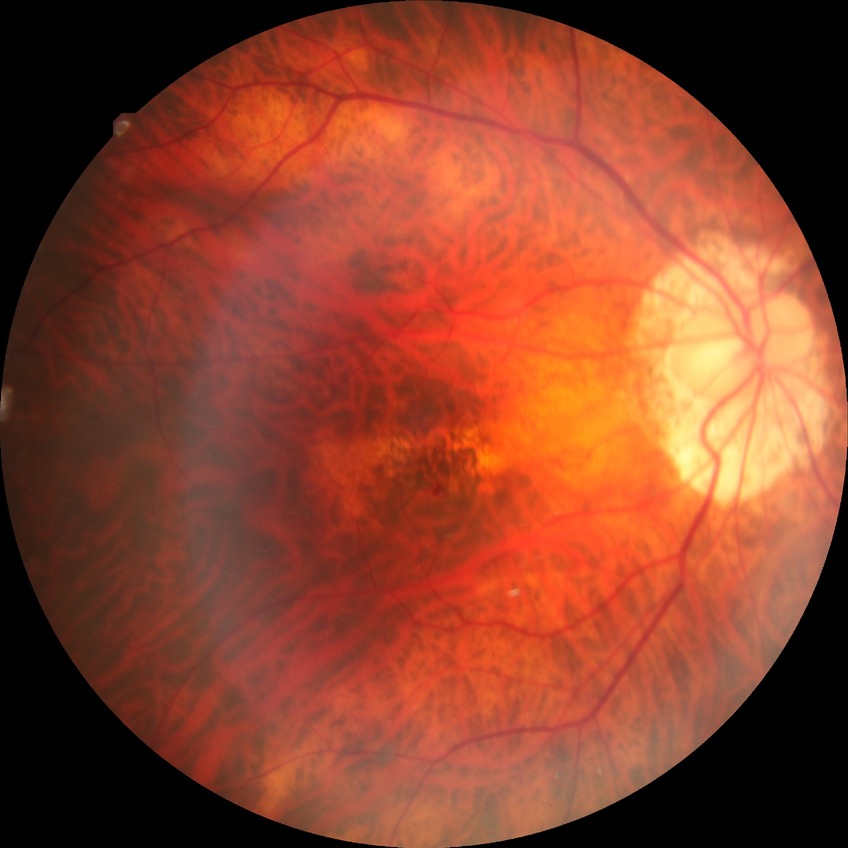
Retinopathy stage is no diabetic retinopathy.